Color fundus photograph: 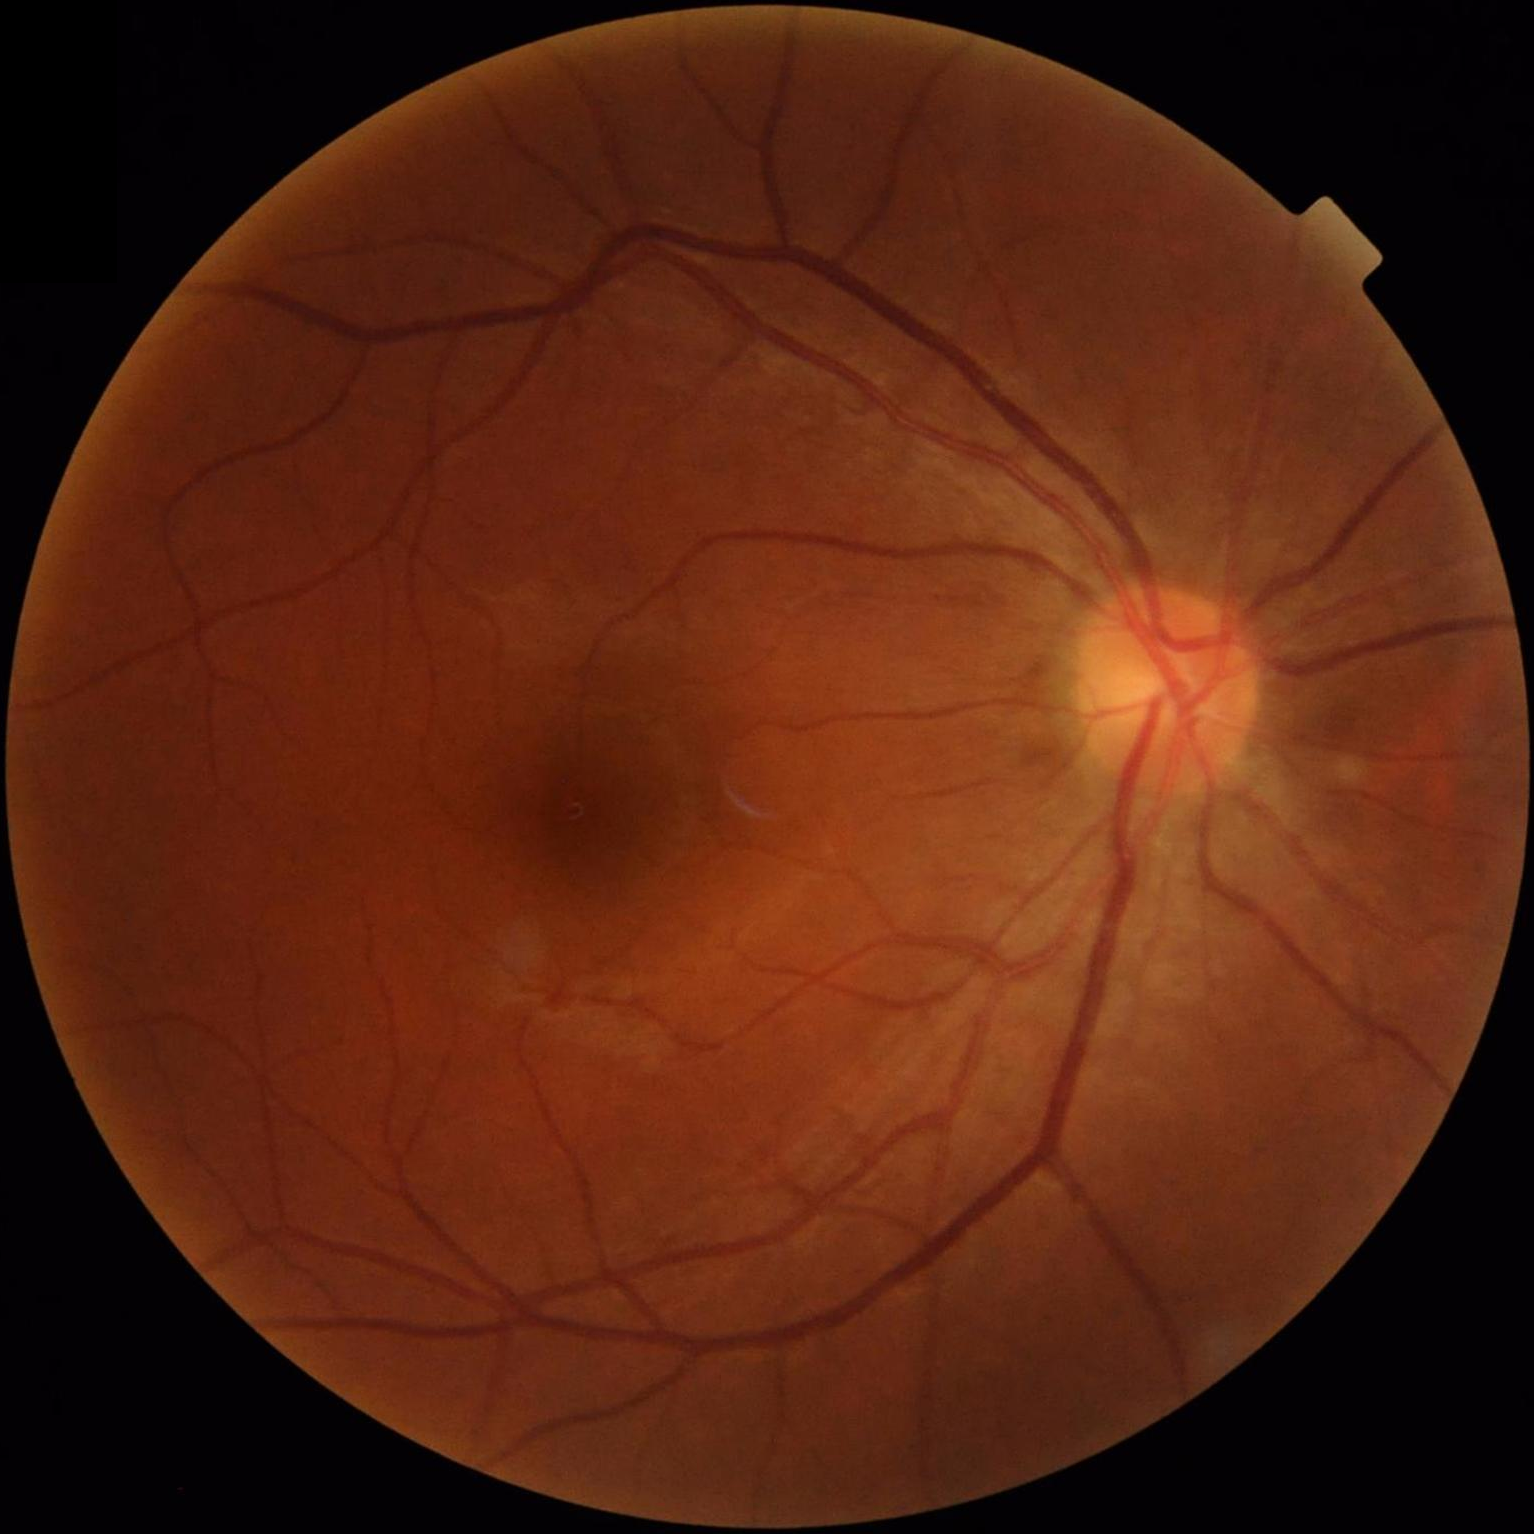 Overall quality is good and the image is gradable. Illumination is even. Vessels and details are readily distinguishable. No noticeable blur.